Camera: Topcon TRC-50DX: 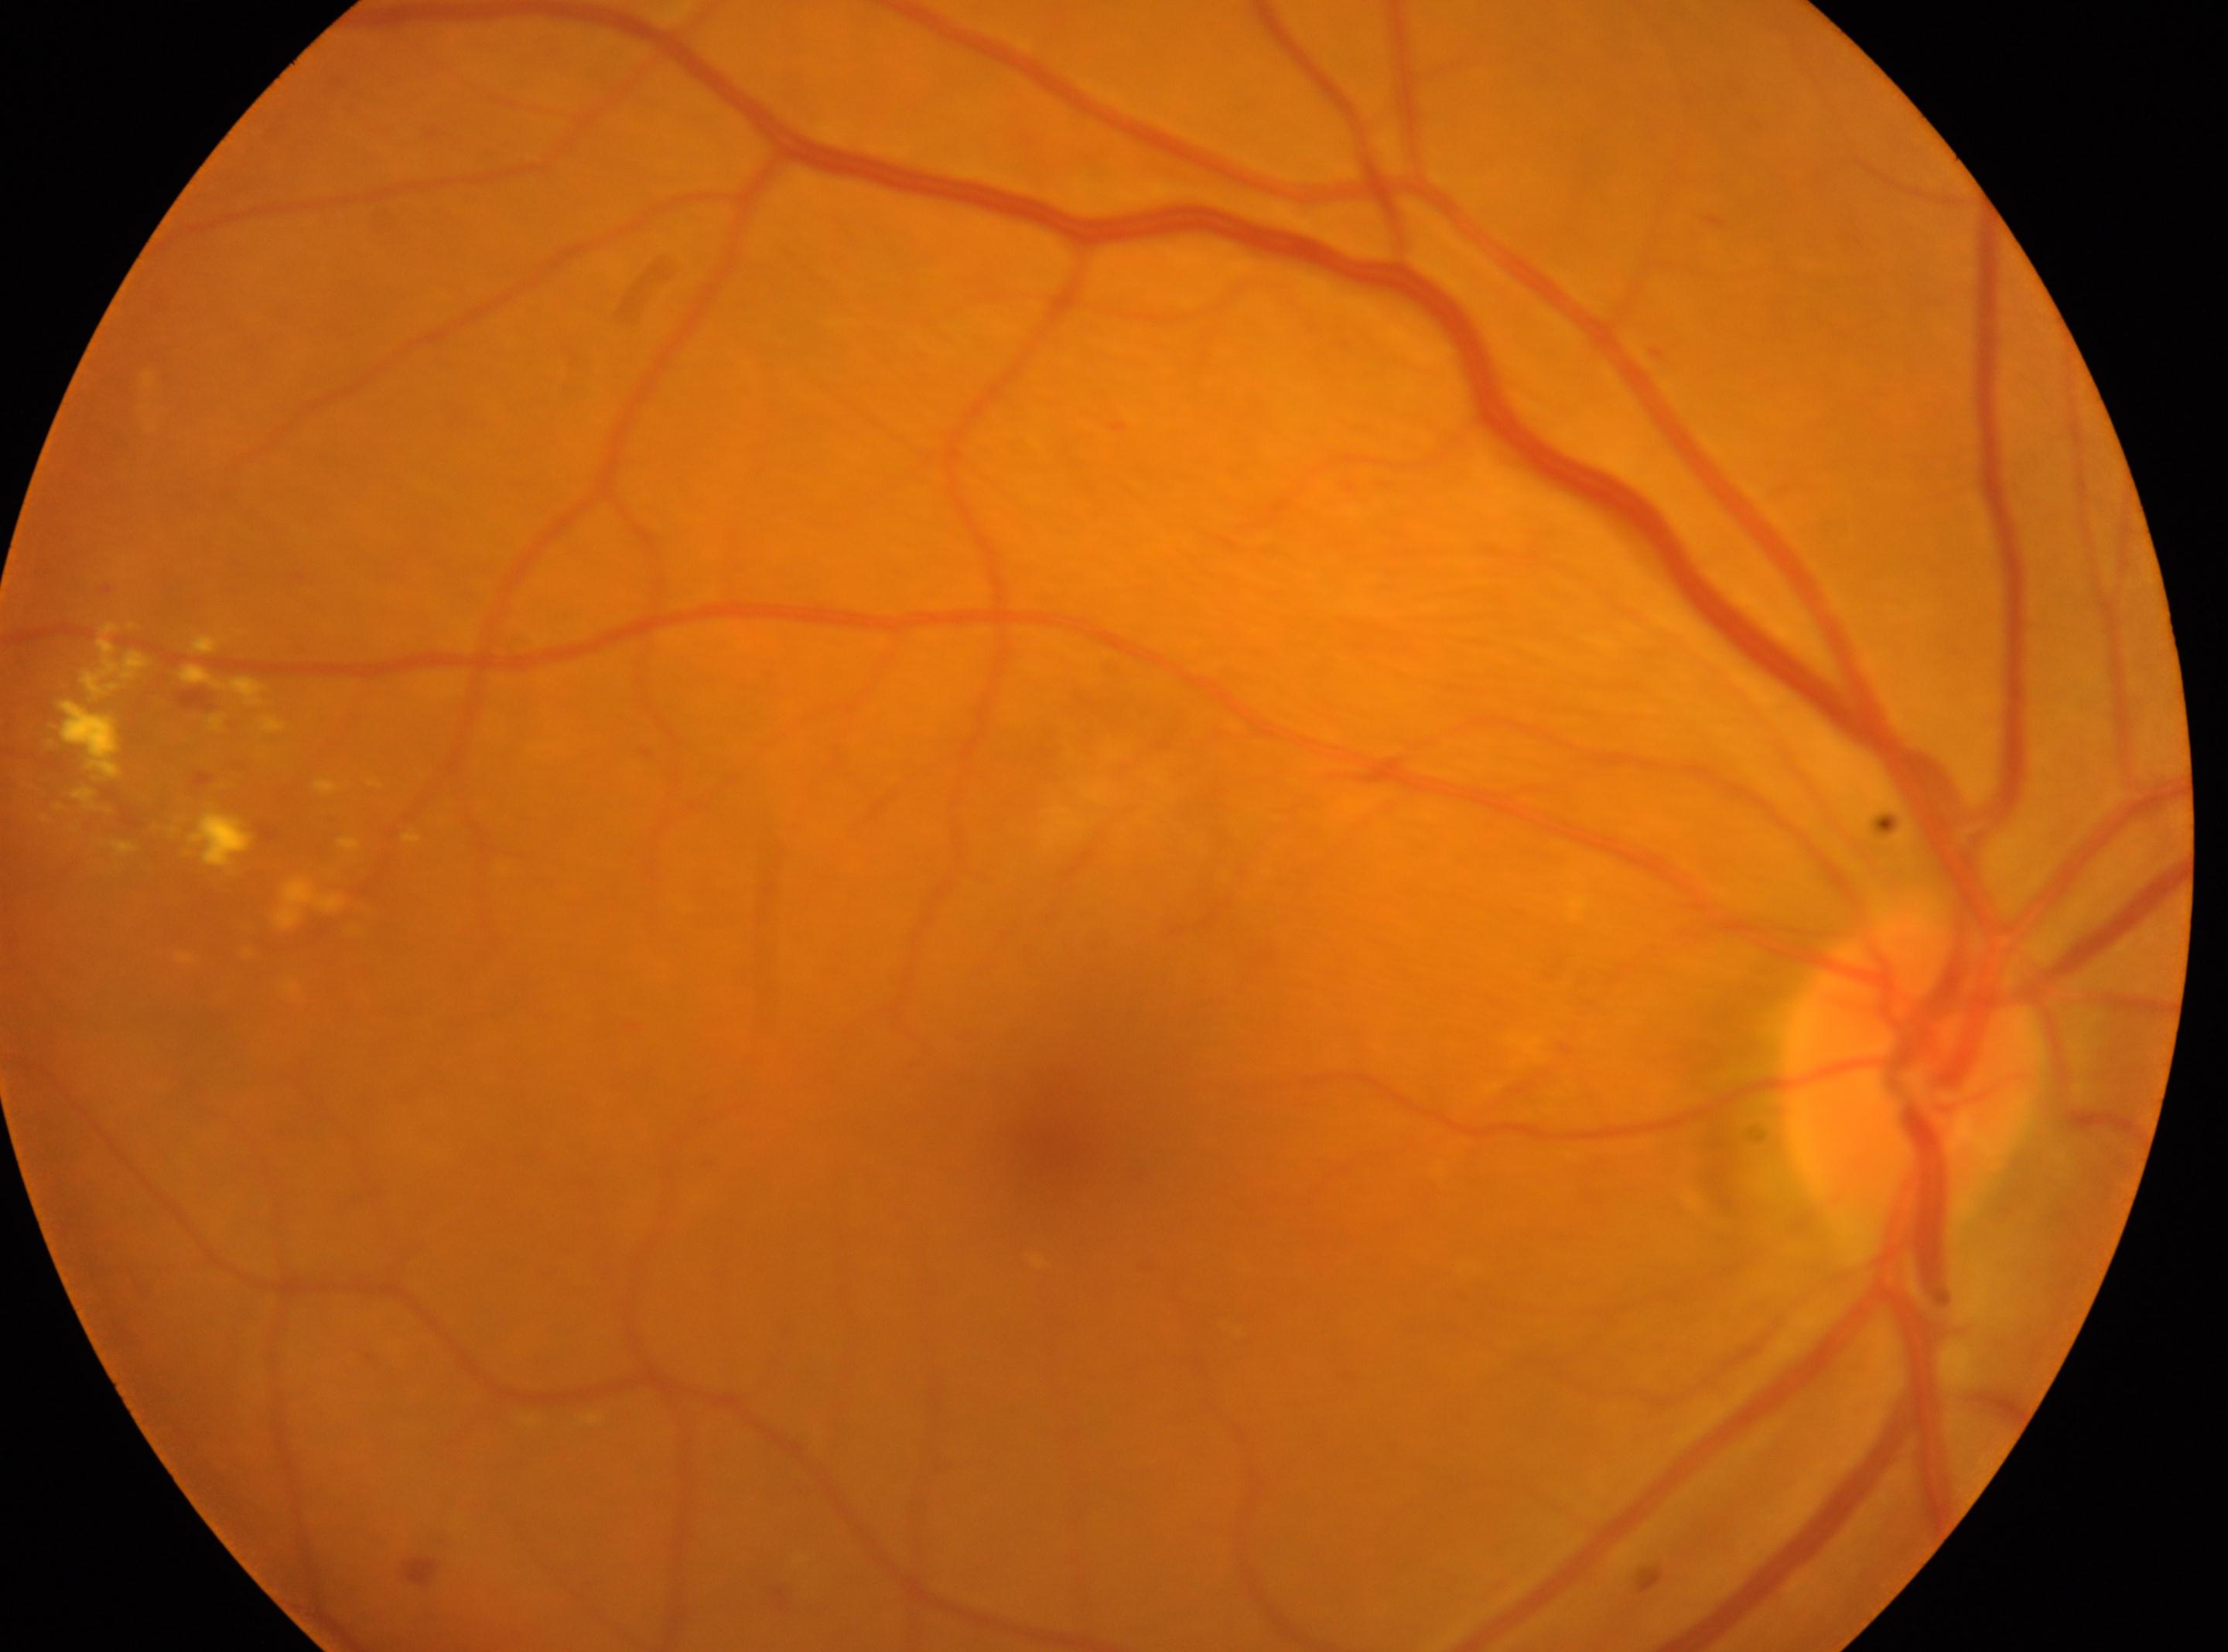

DR severity=grade 2 | fovea=[1060, 1151] | the right eye | disc center=[1908, 1072].